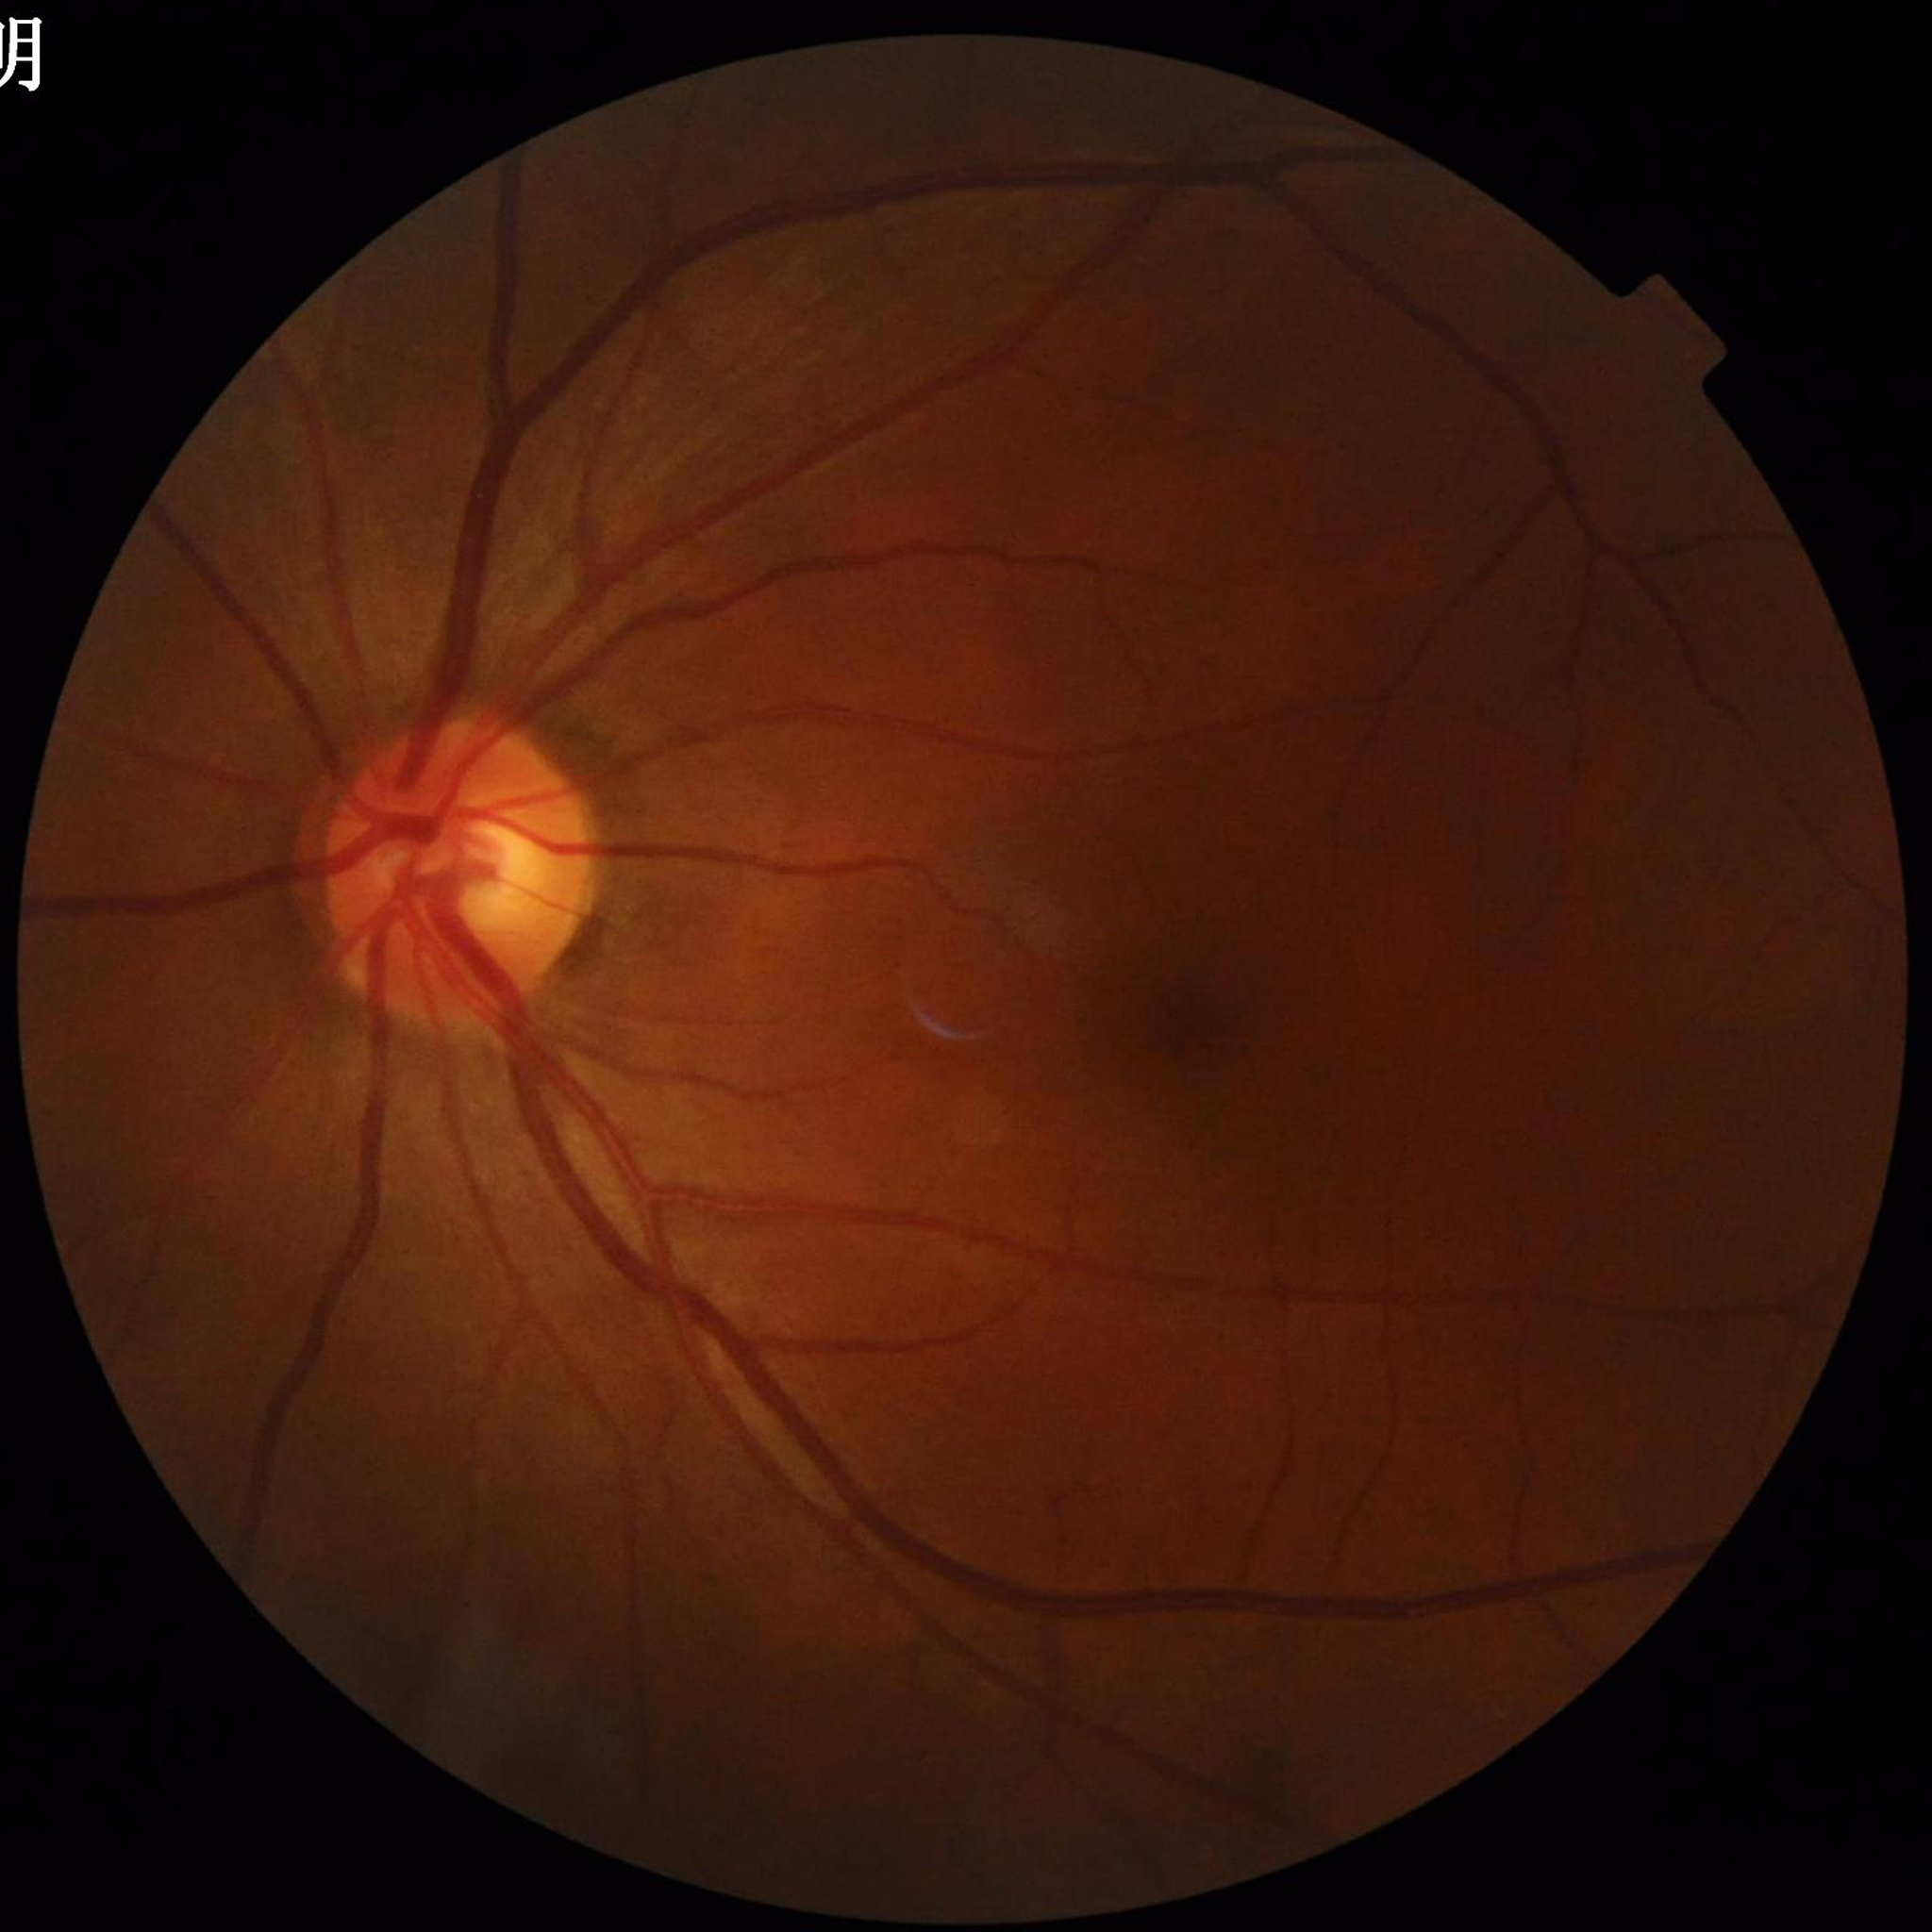

Disease: glaucoma